Wide-field contact fundus photograph of an infant · 1440x1080px: 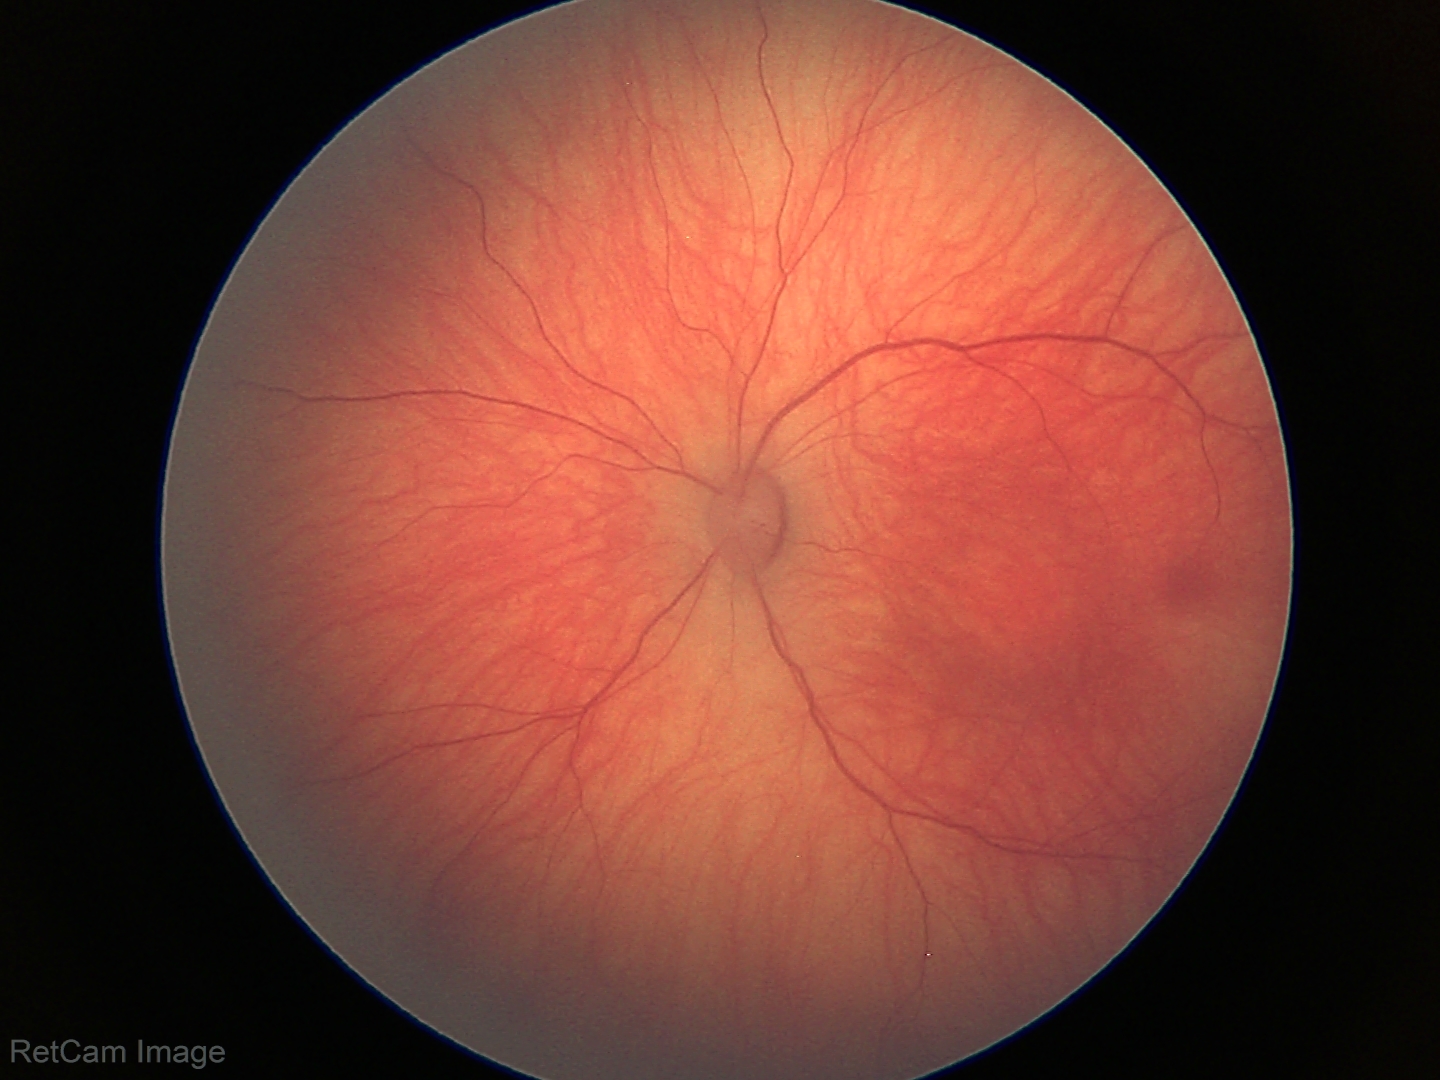 Screening: physiological finding.